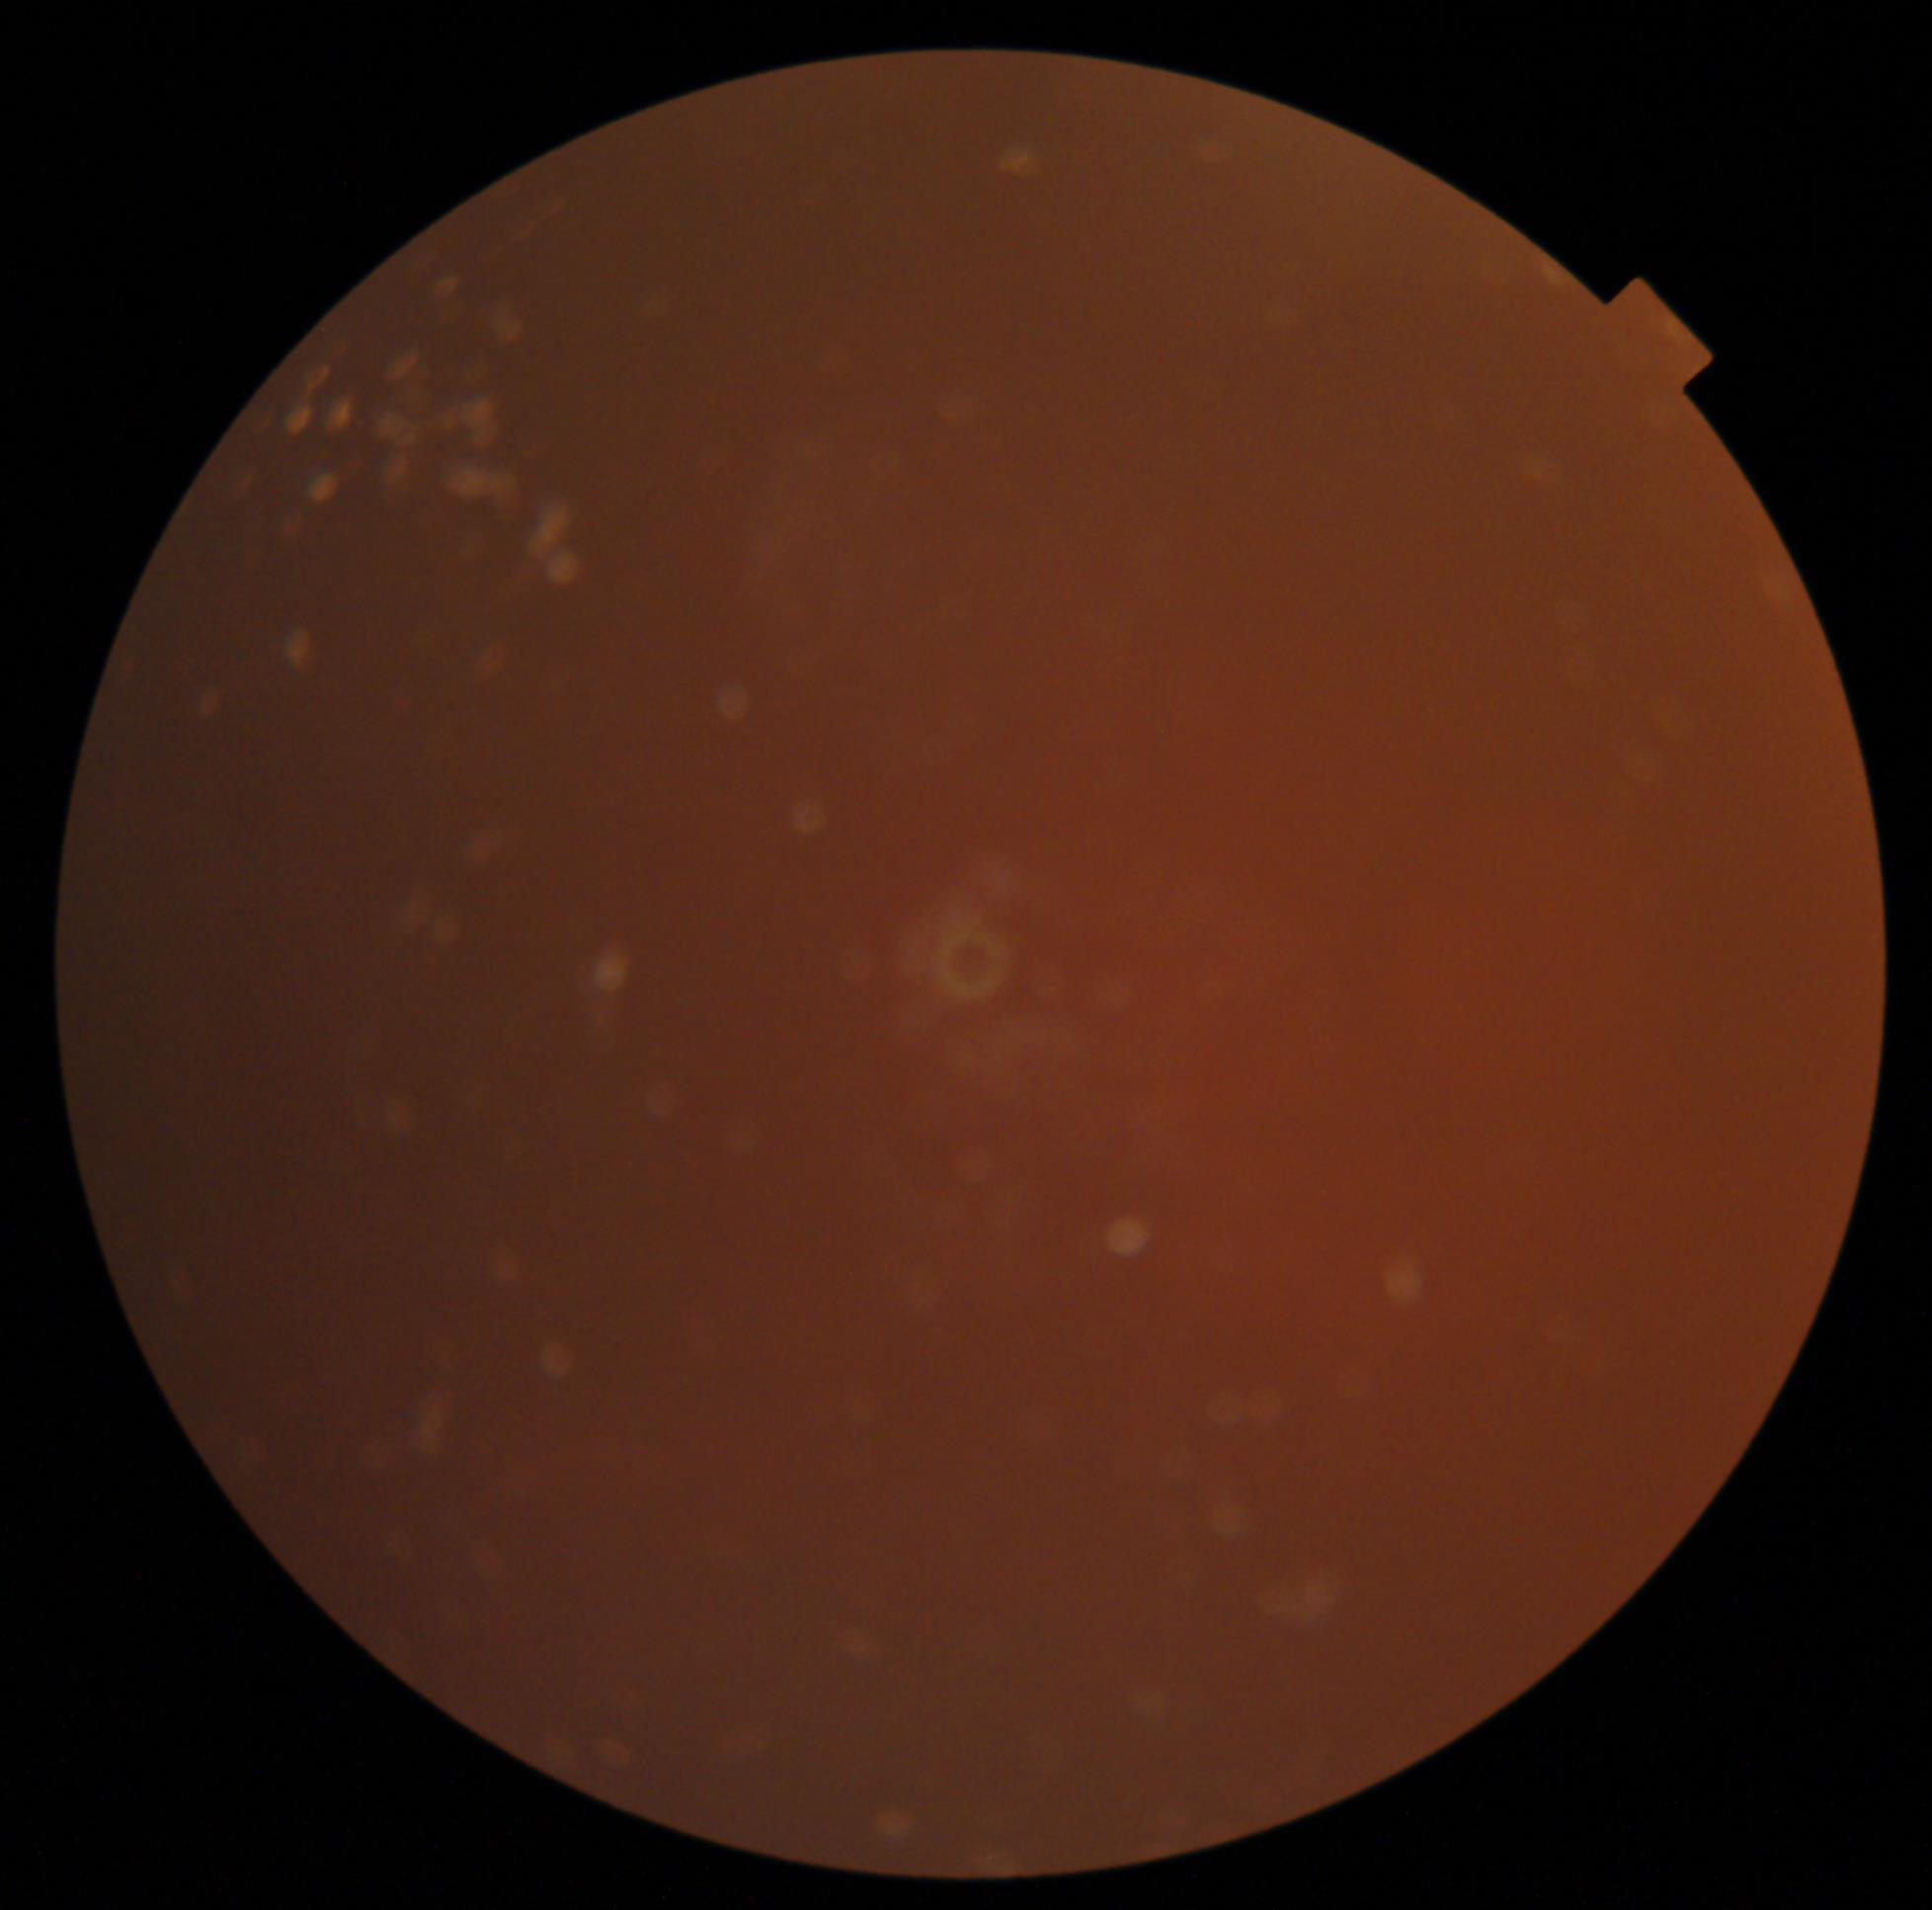 diabetic retinopathy (DR): ungradable, image quality: insufficient for DR assessment.